1240x1240; pediatric retinal photograph (wide-field); acquired on the Phoenix ICON: 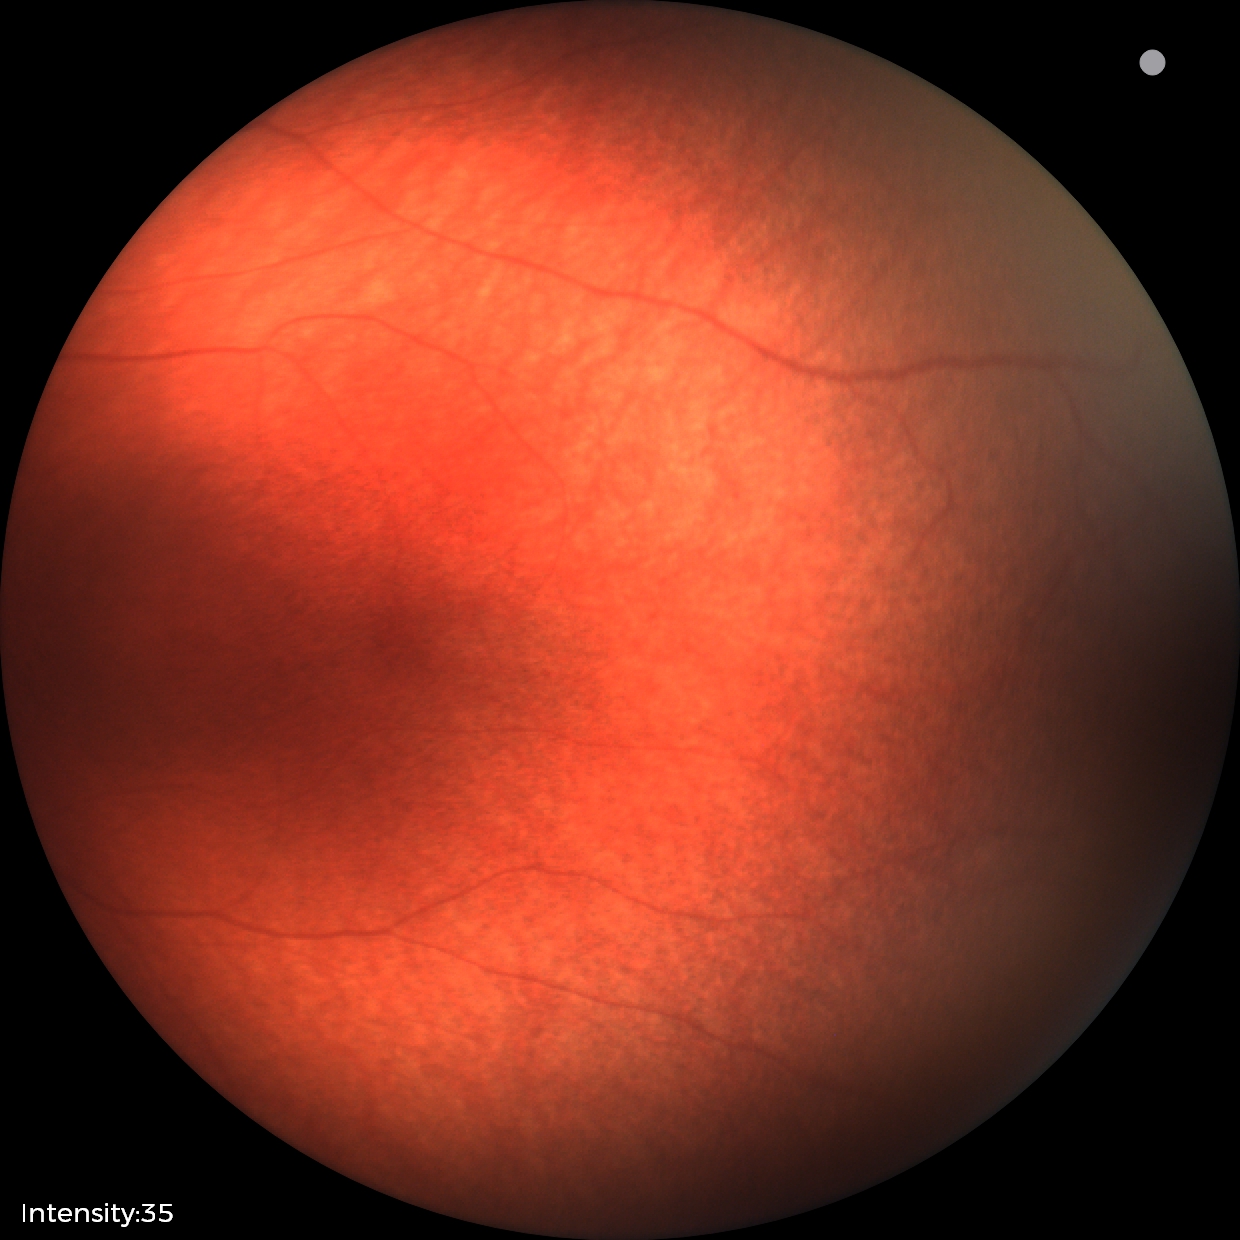 Screening examination diagnosed as physiological.